848x848: 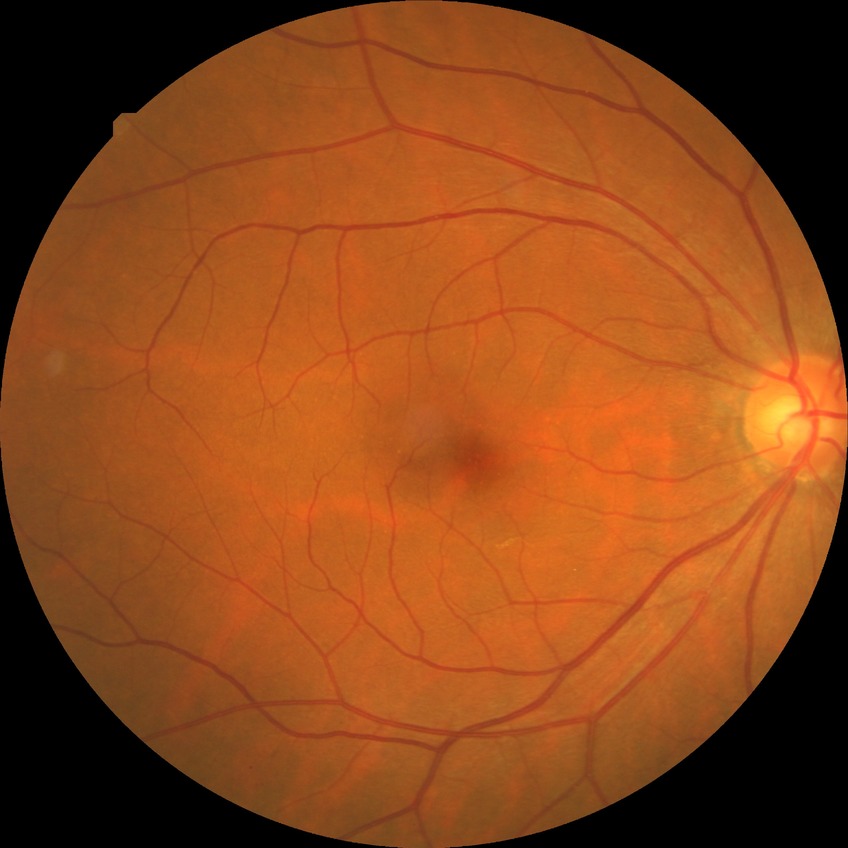 * DR impression — negative for DR
* modified Davis grade — NDR